Captured after pupil dilation
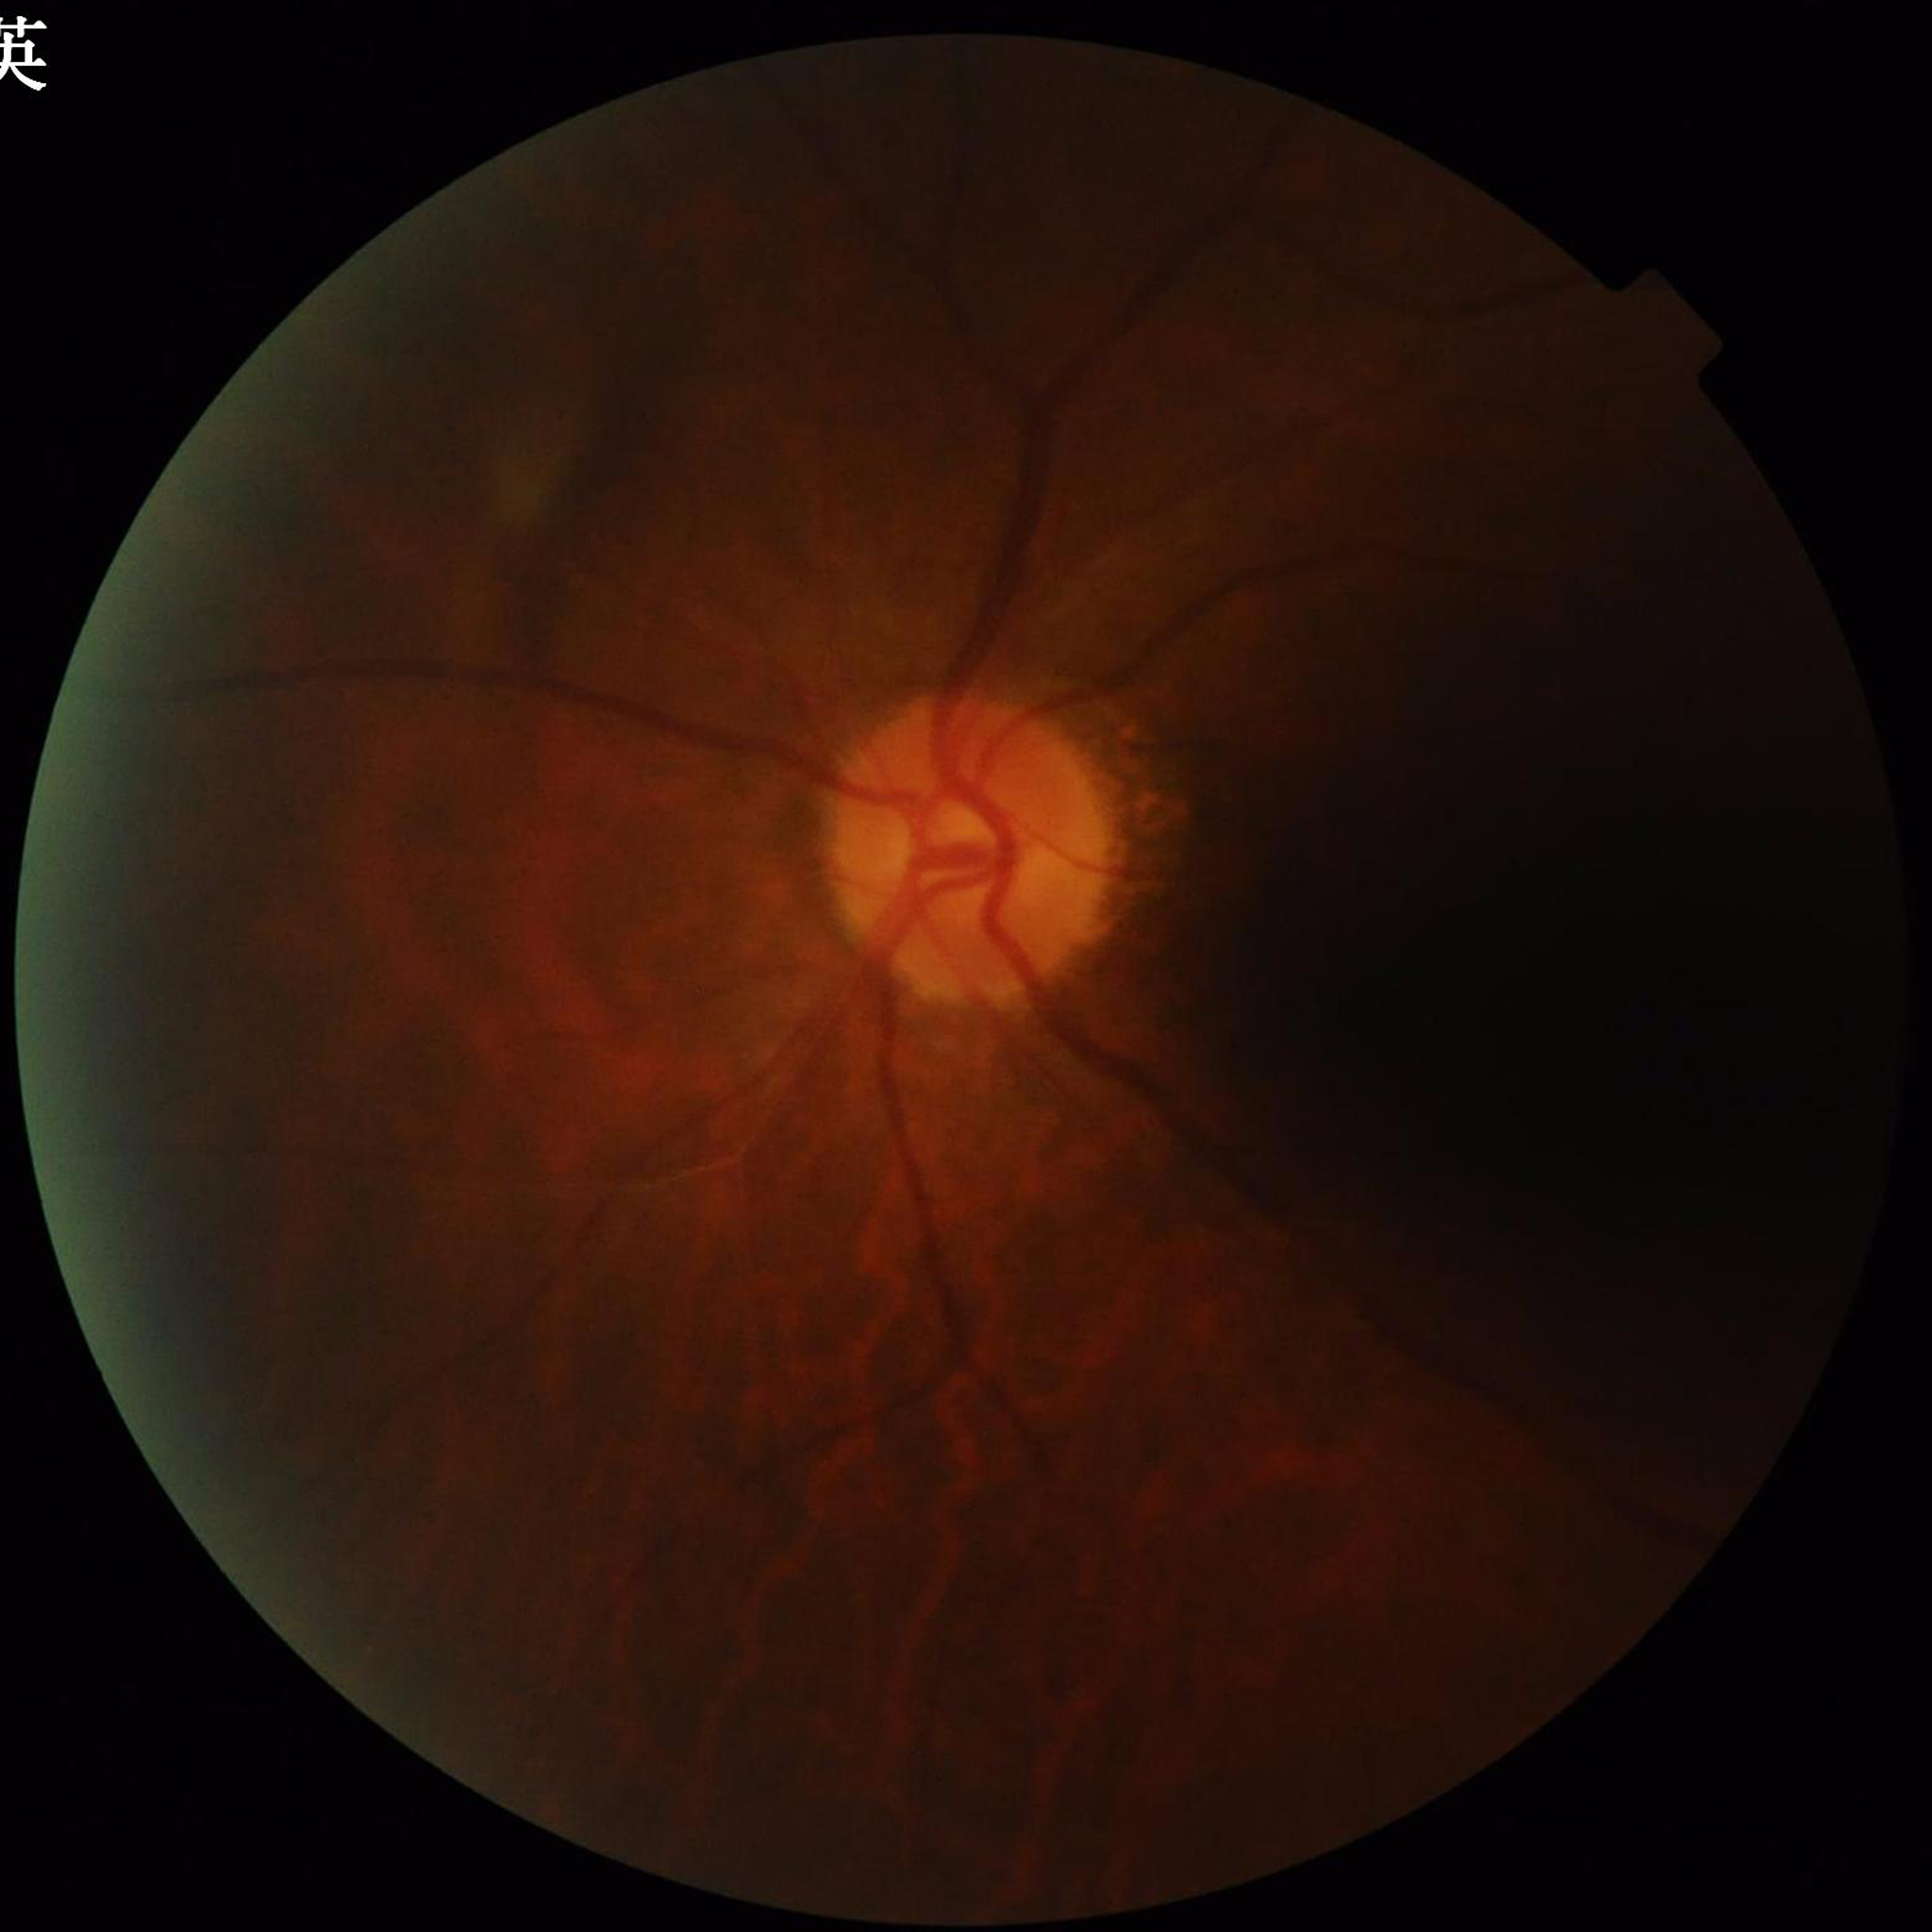

Image quality: illumination/color distortion present, low contrast, blur present. The patient was diagnosed with glaucoma.